Graded on the modified Davis scale; 848x848px: 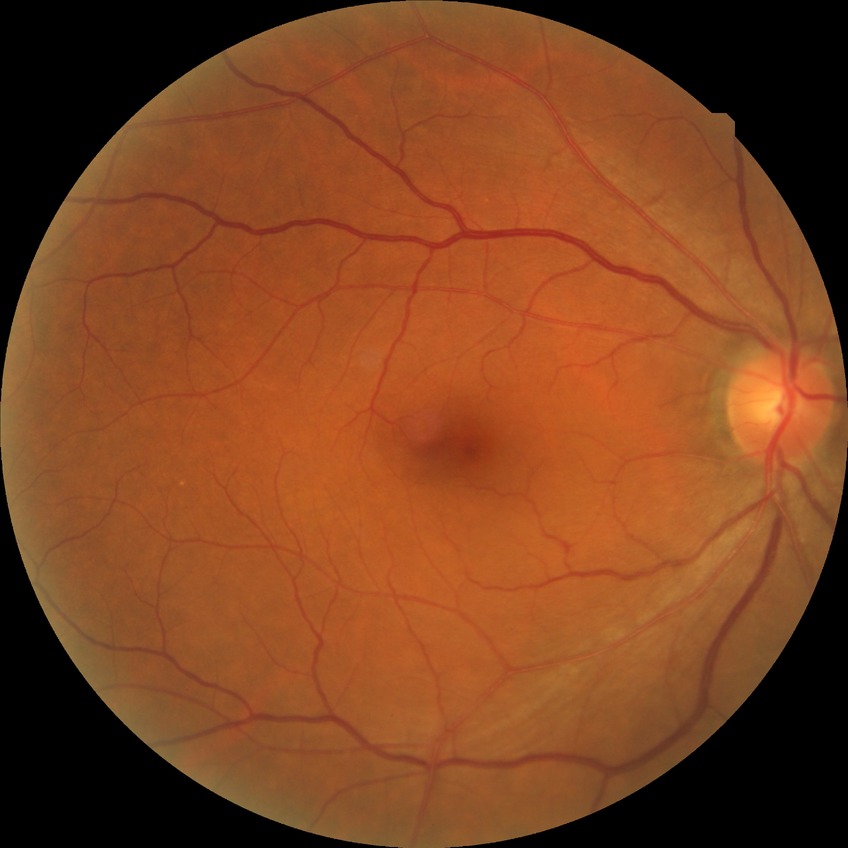

{"davis_grade": "no diabetic retinopathy"}